Fundus photo:
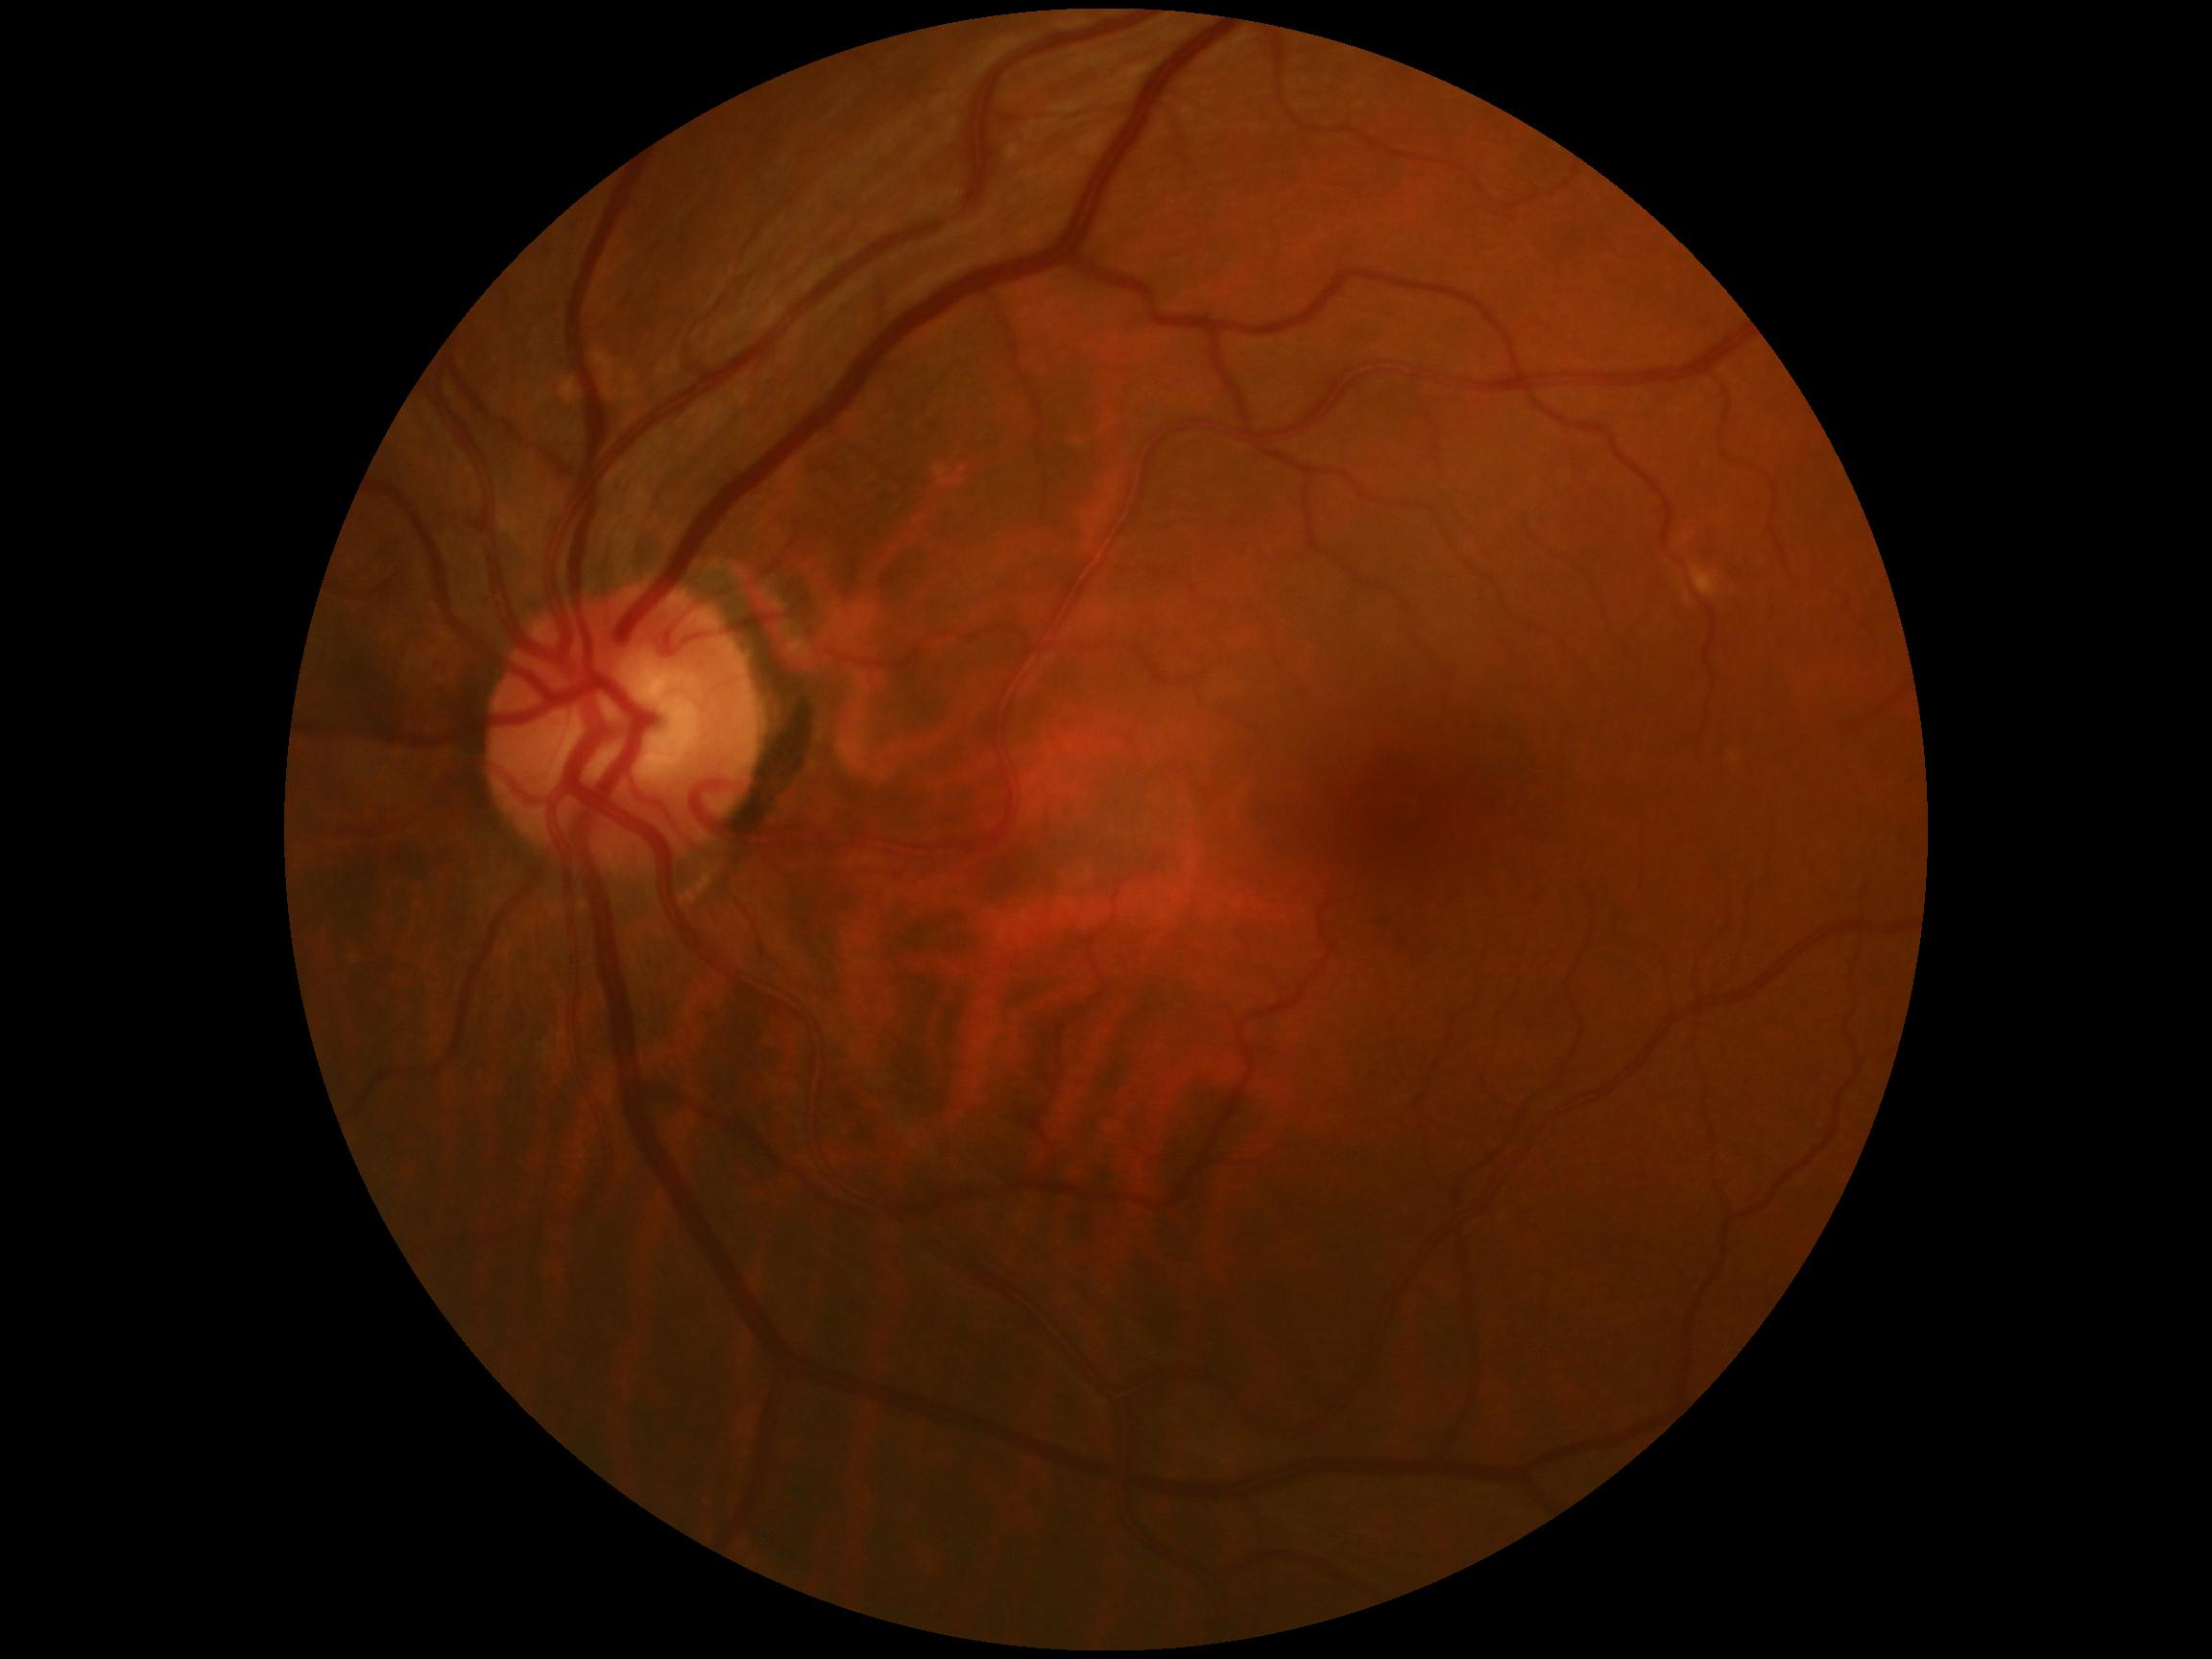
DR severity: 0.